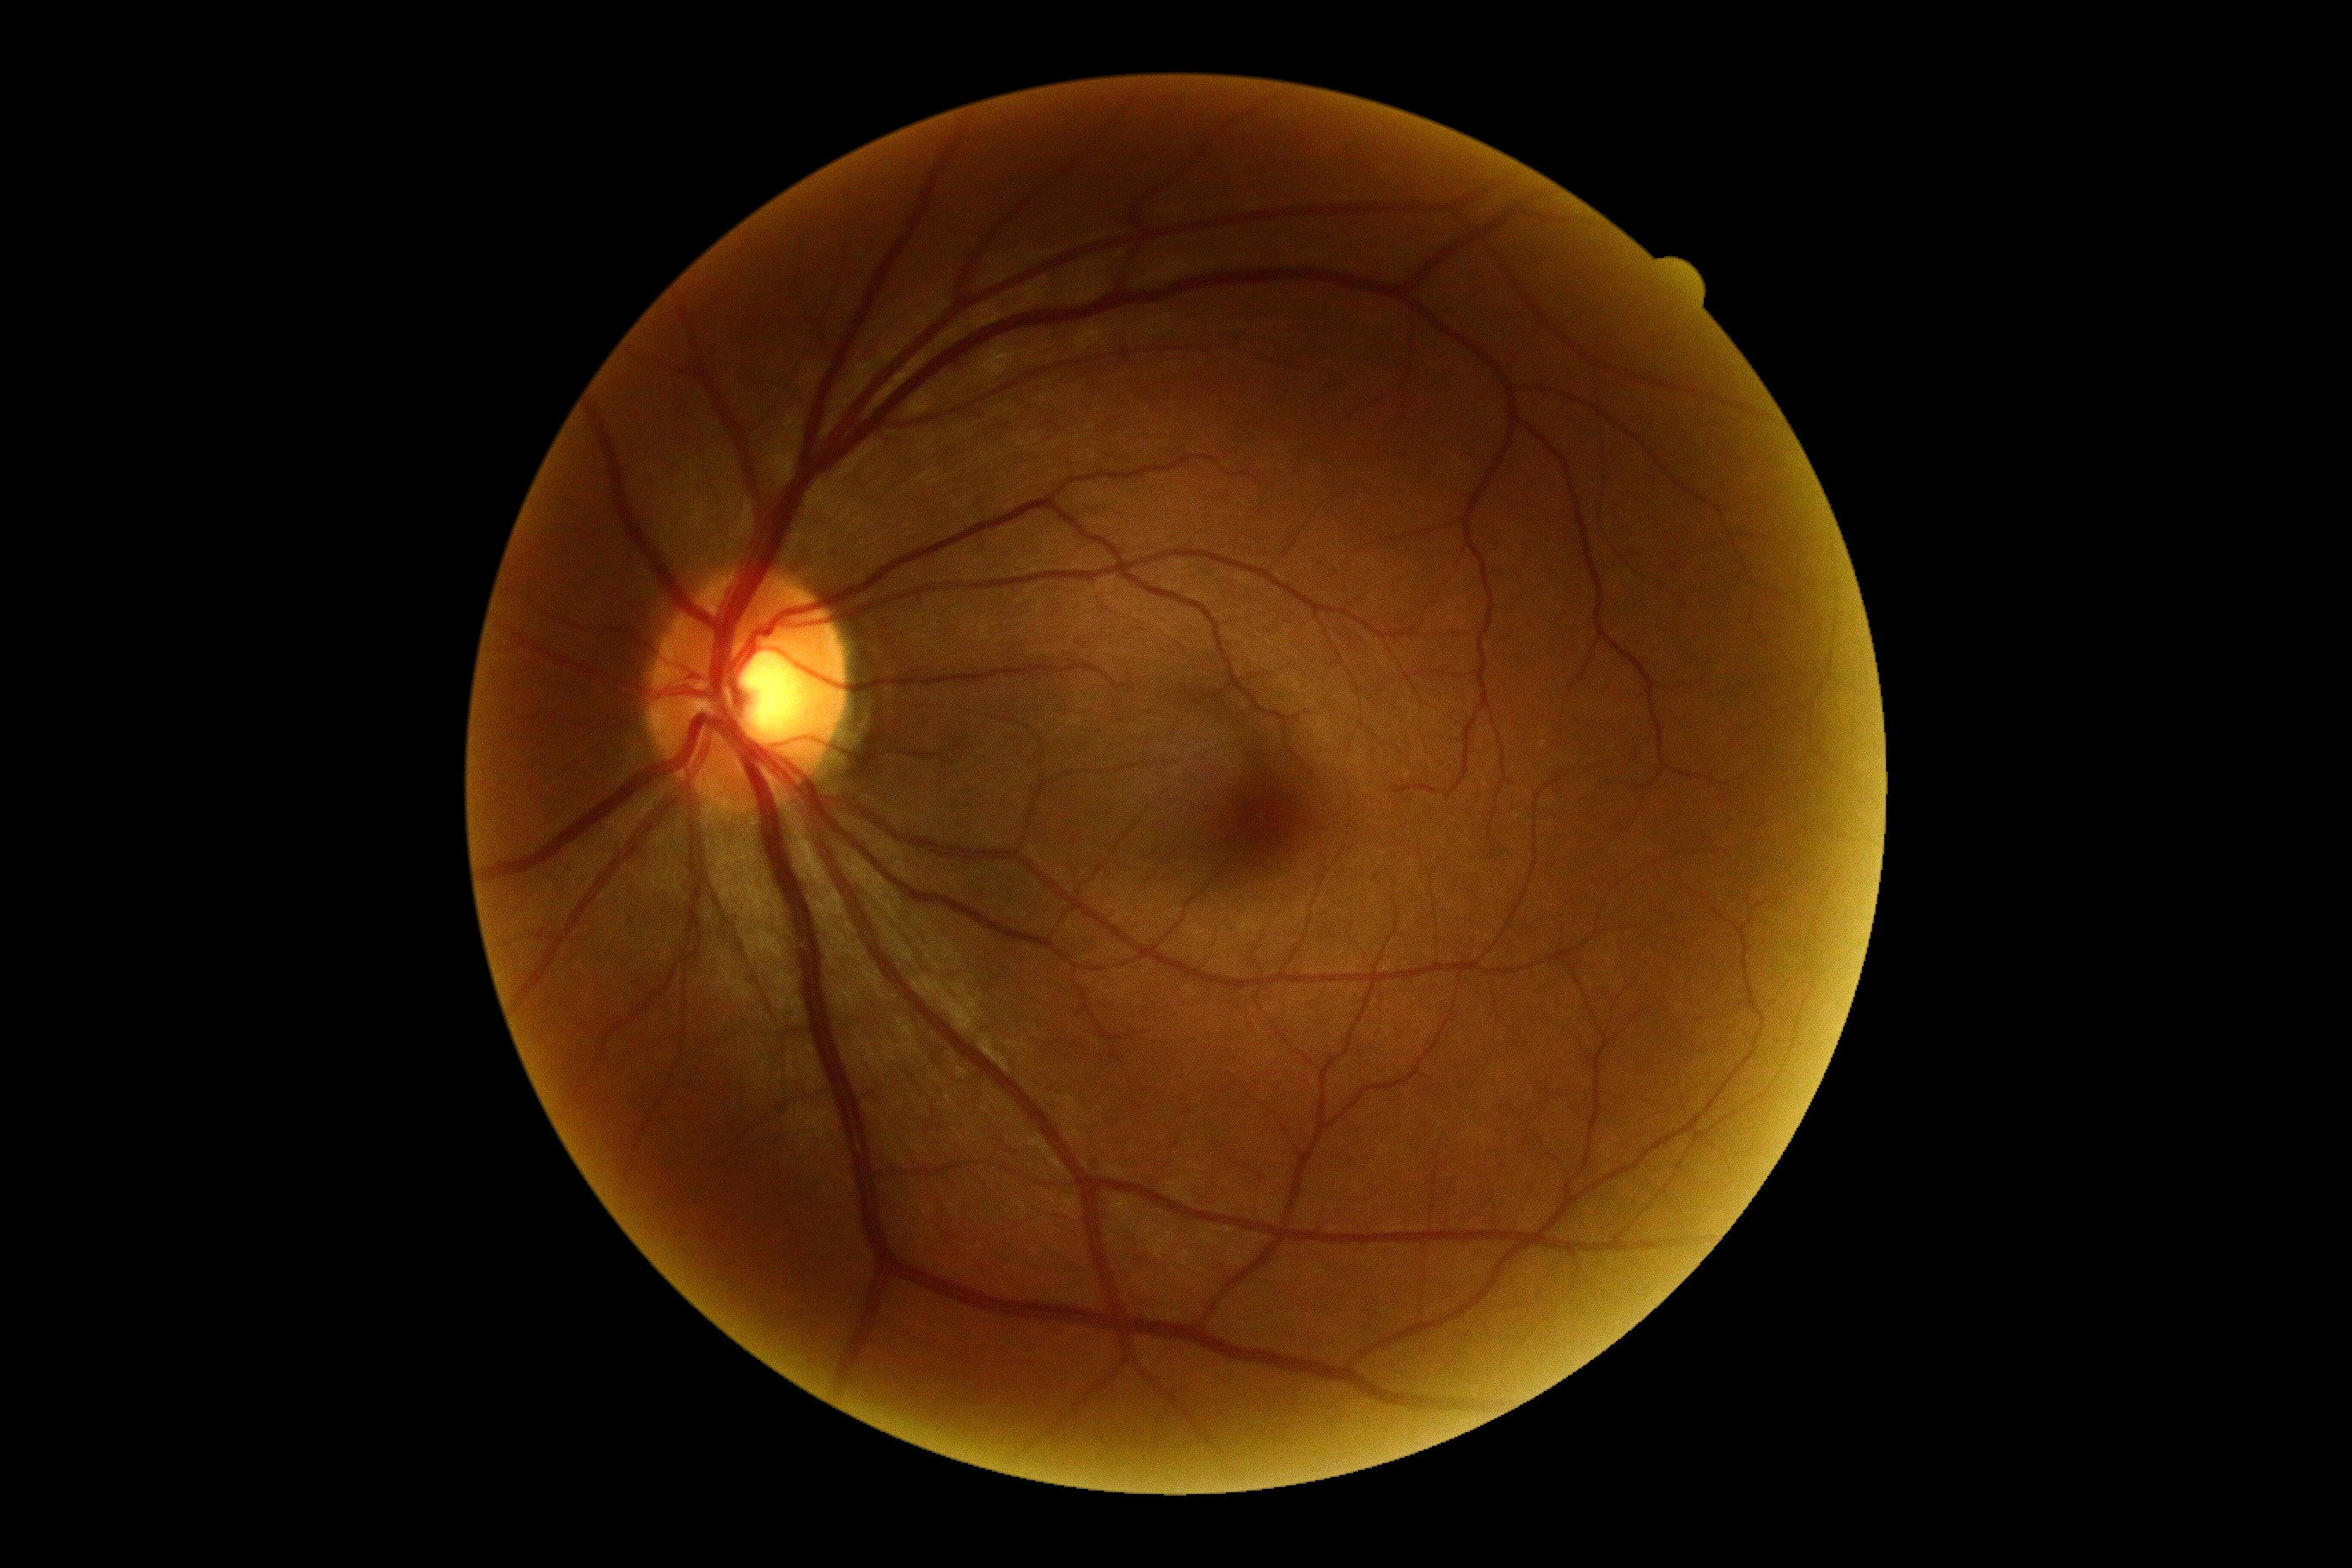

Retinopathy is grade 0 (no apparent retinopathy). No apparent diabetic retinopathy.